Color fundus image, 45° field of view, 2352x1568px.
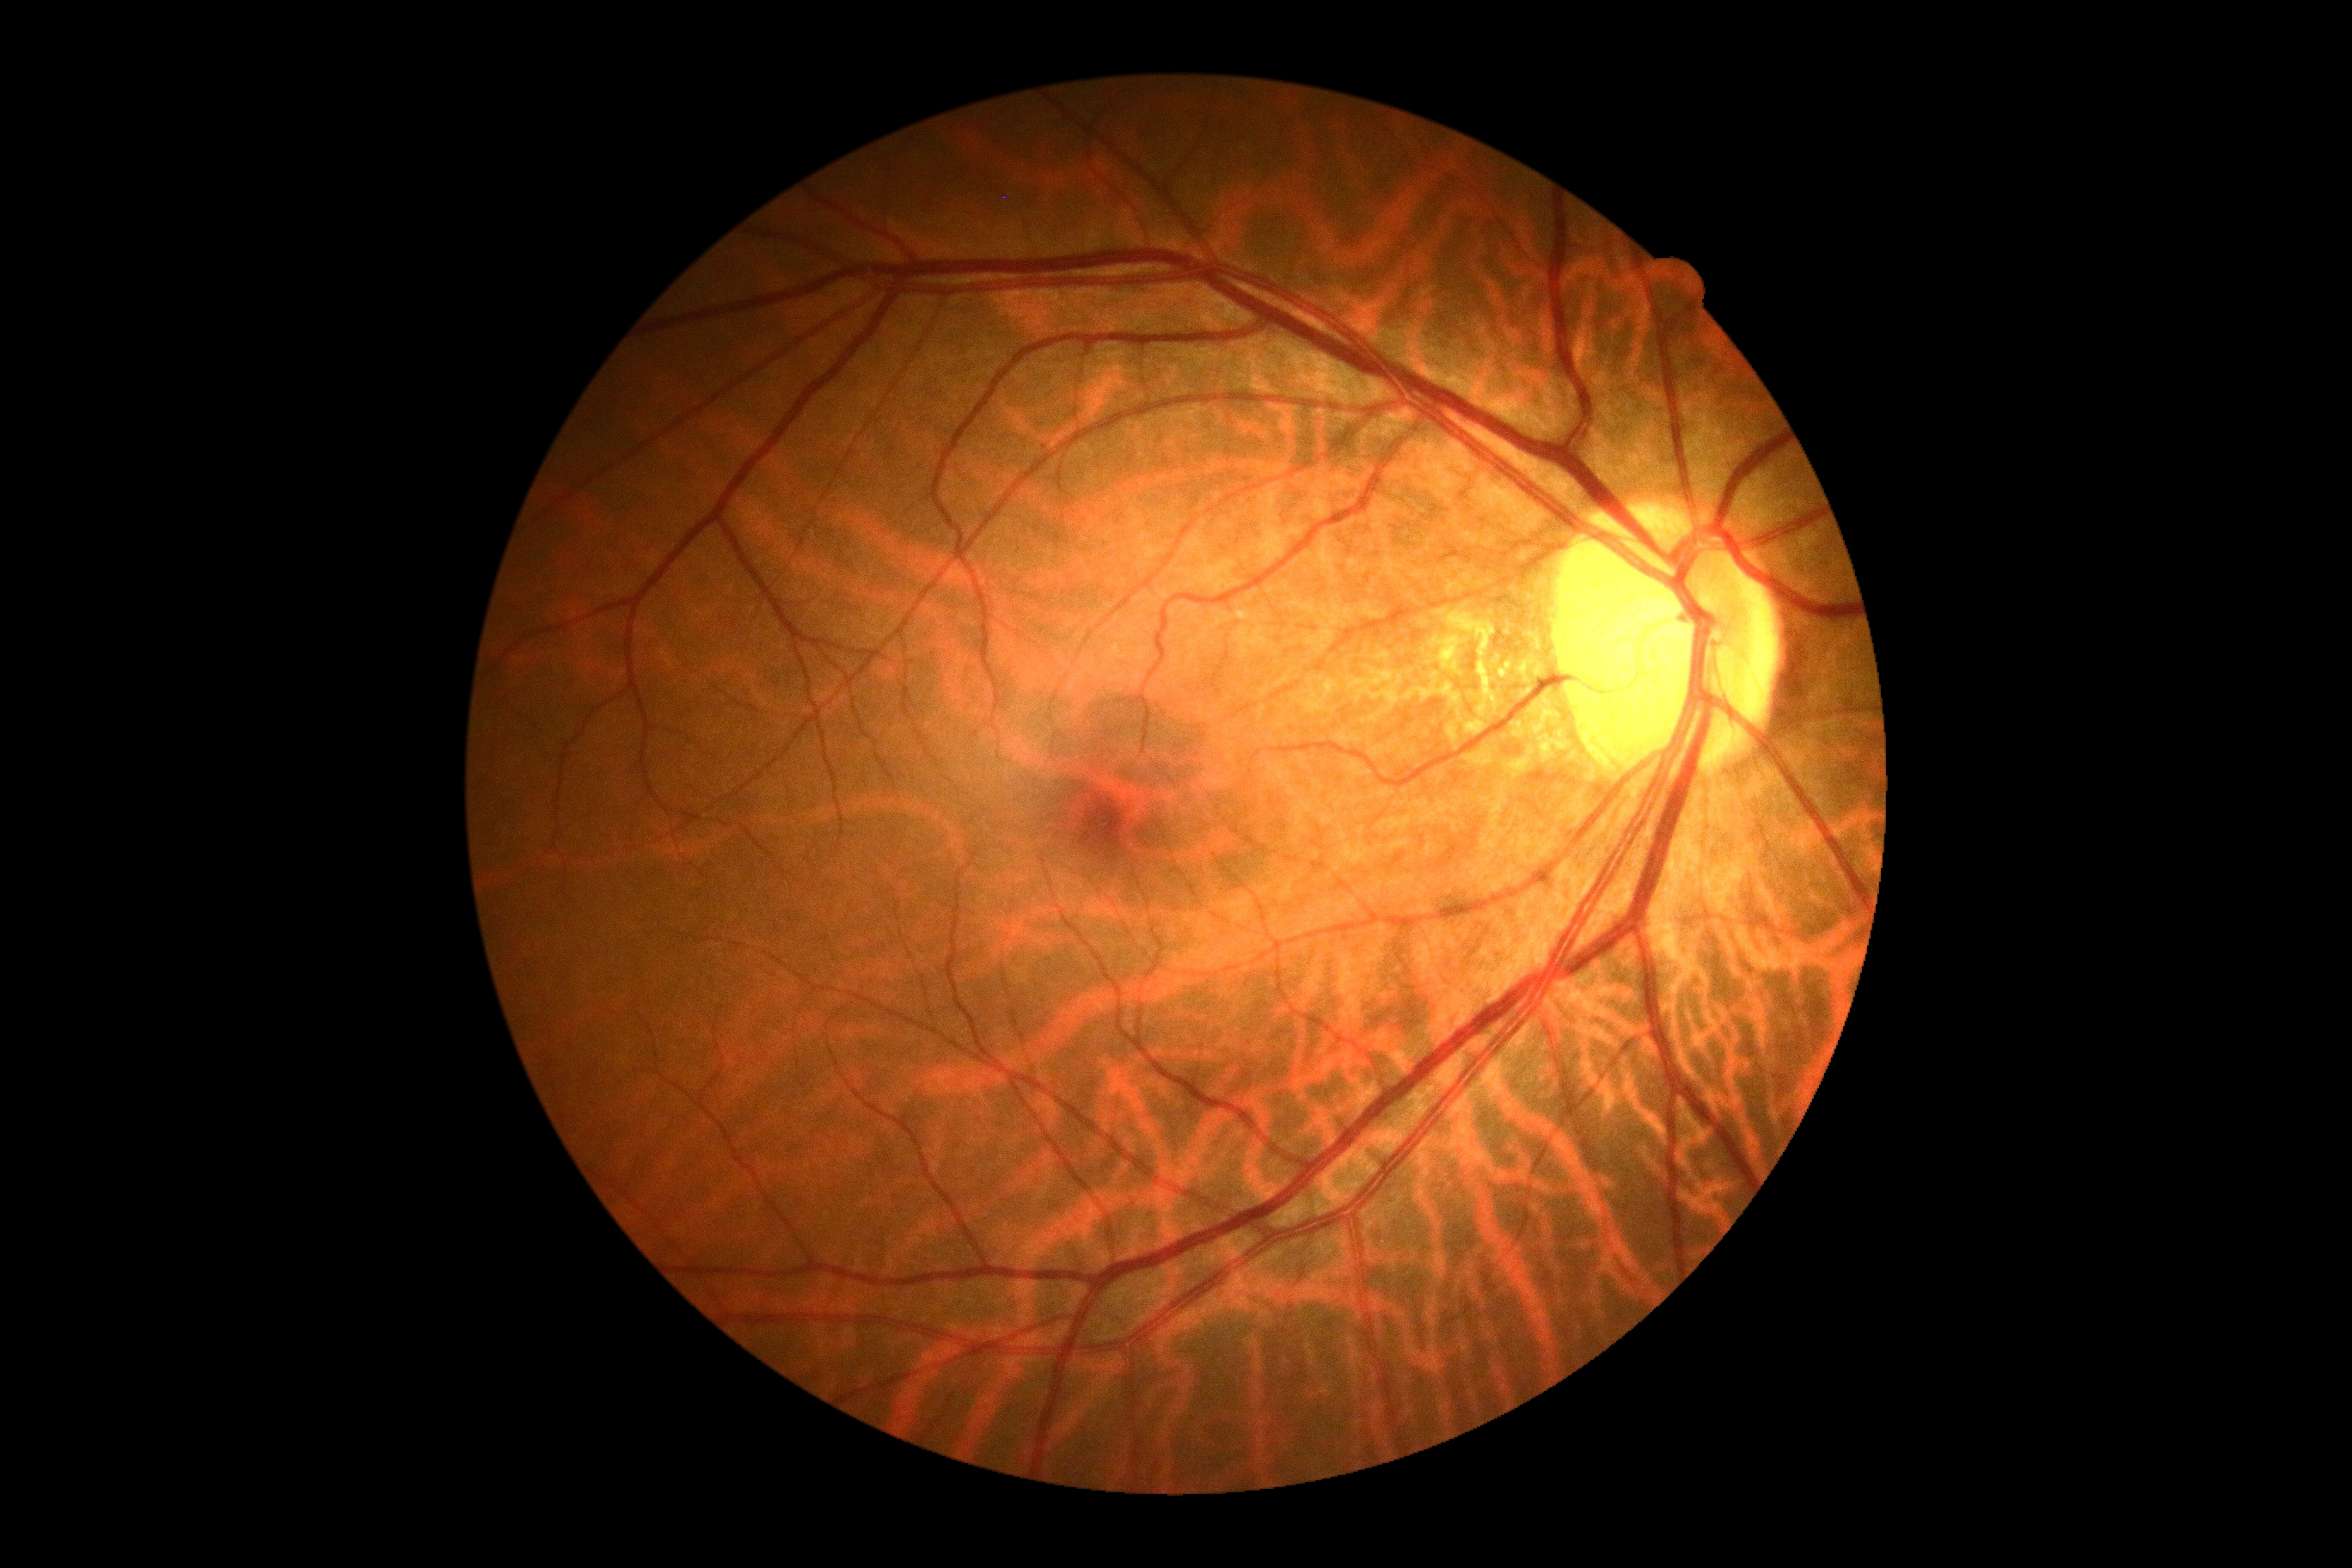 DR impression = no DR findings; diabetic retinopathy = no apparent diabetic retinopathy (grade 0).